Wide-field fundus photograph from neonatal ROP screening · camera: Clarity RetCam 3 (130° FOV) · 640 x 480 pixels — 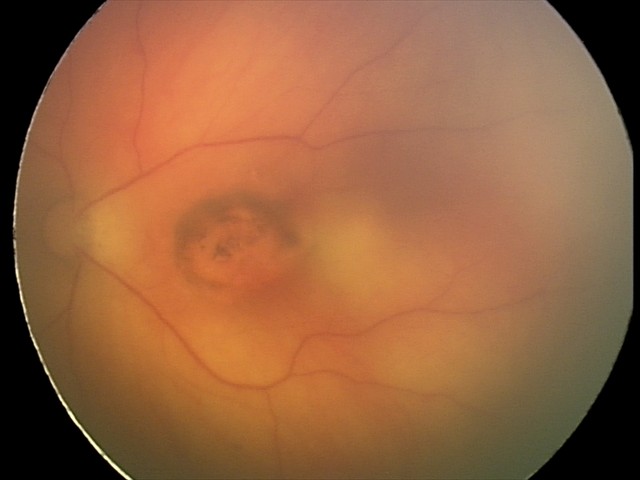 Examination diagnosed as toxoplasmosis chorioretinitis.